CFP:
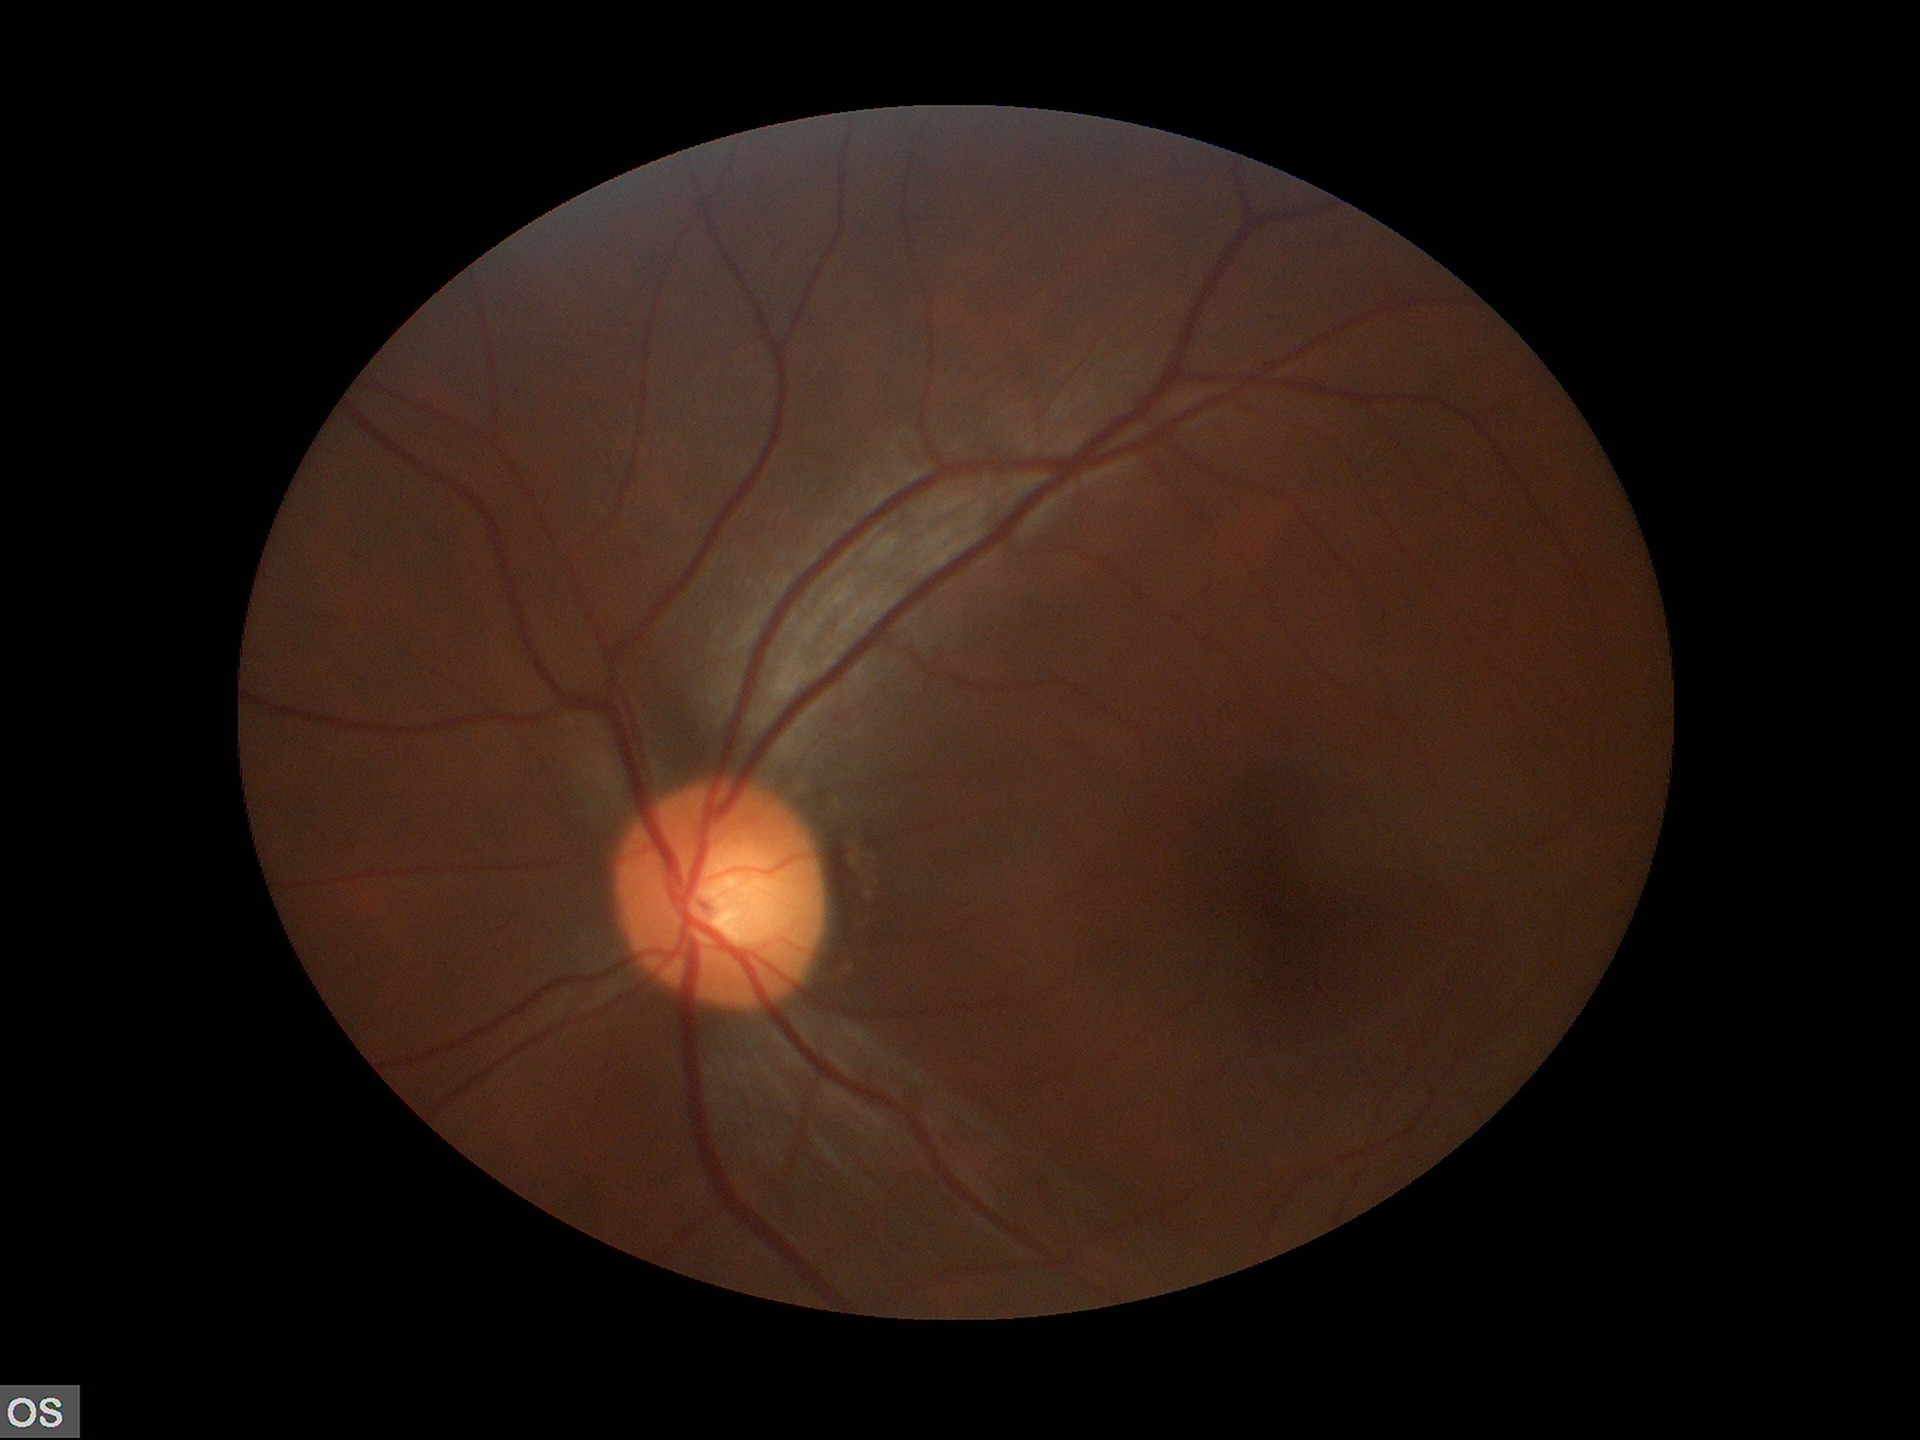

Negative for glaucoma suspicion. Horizontal cup-to-disc ratio (HCDR) of 0.54. Vertical C/D ratio (VCDR) is 0.50.